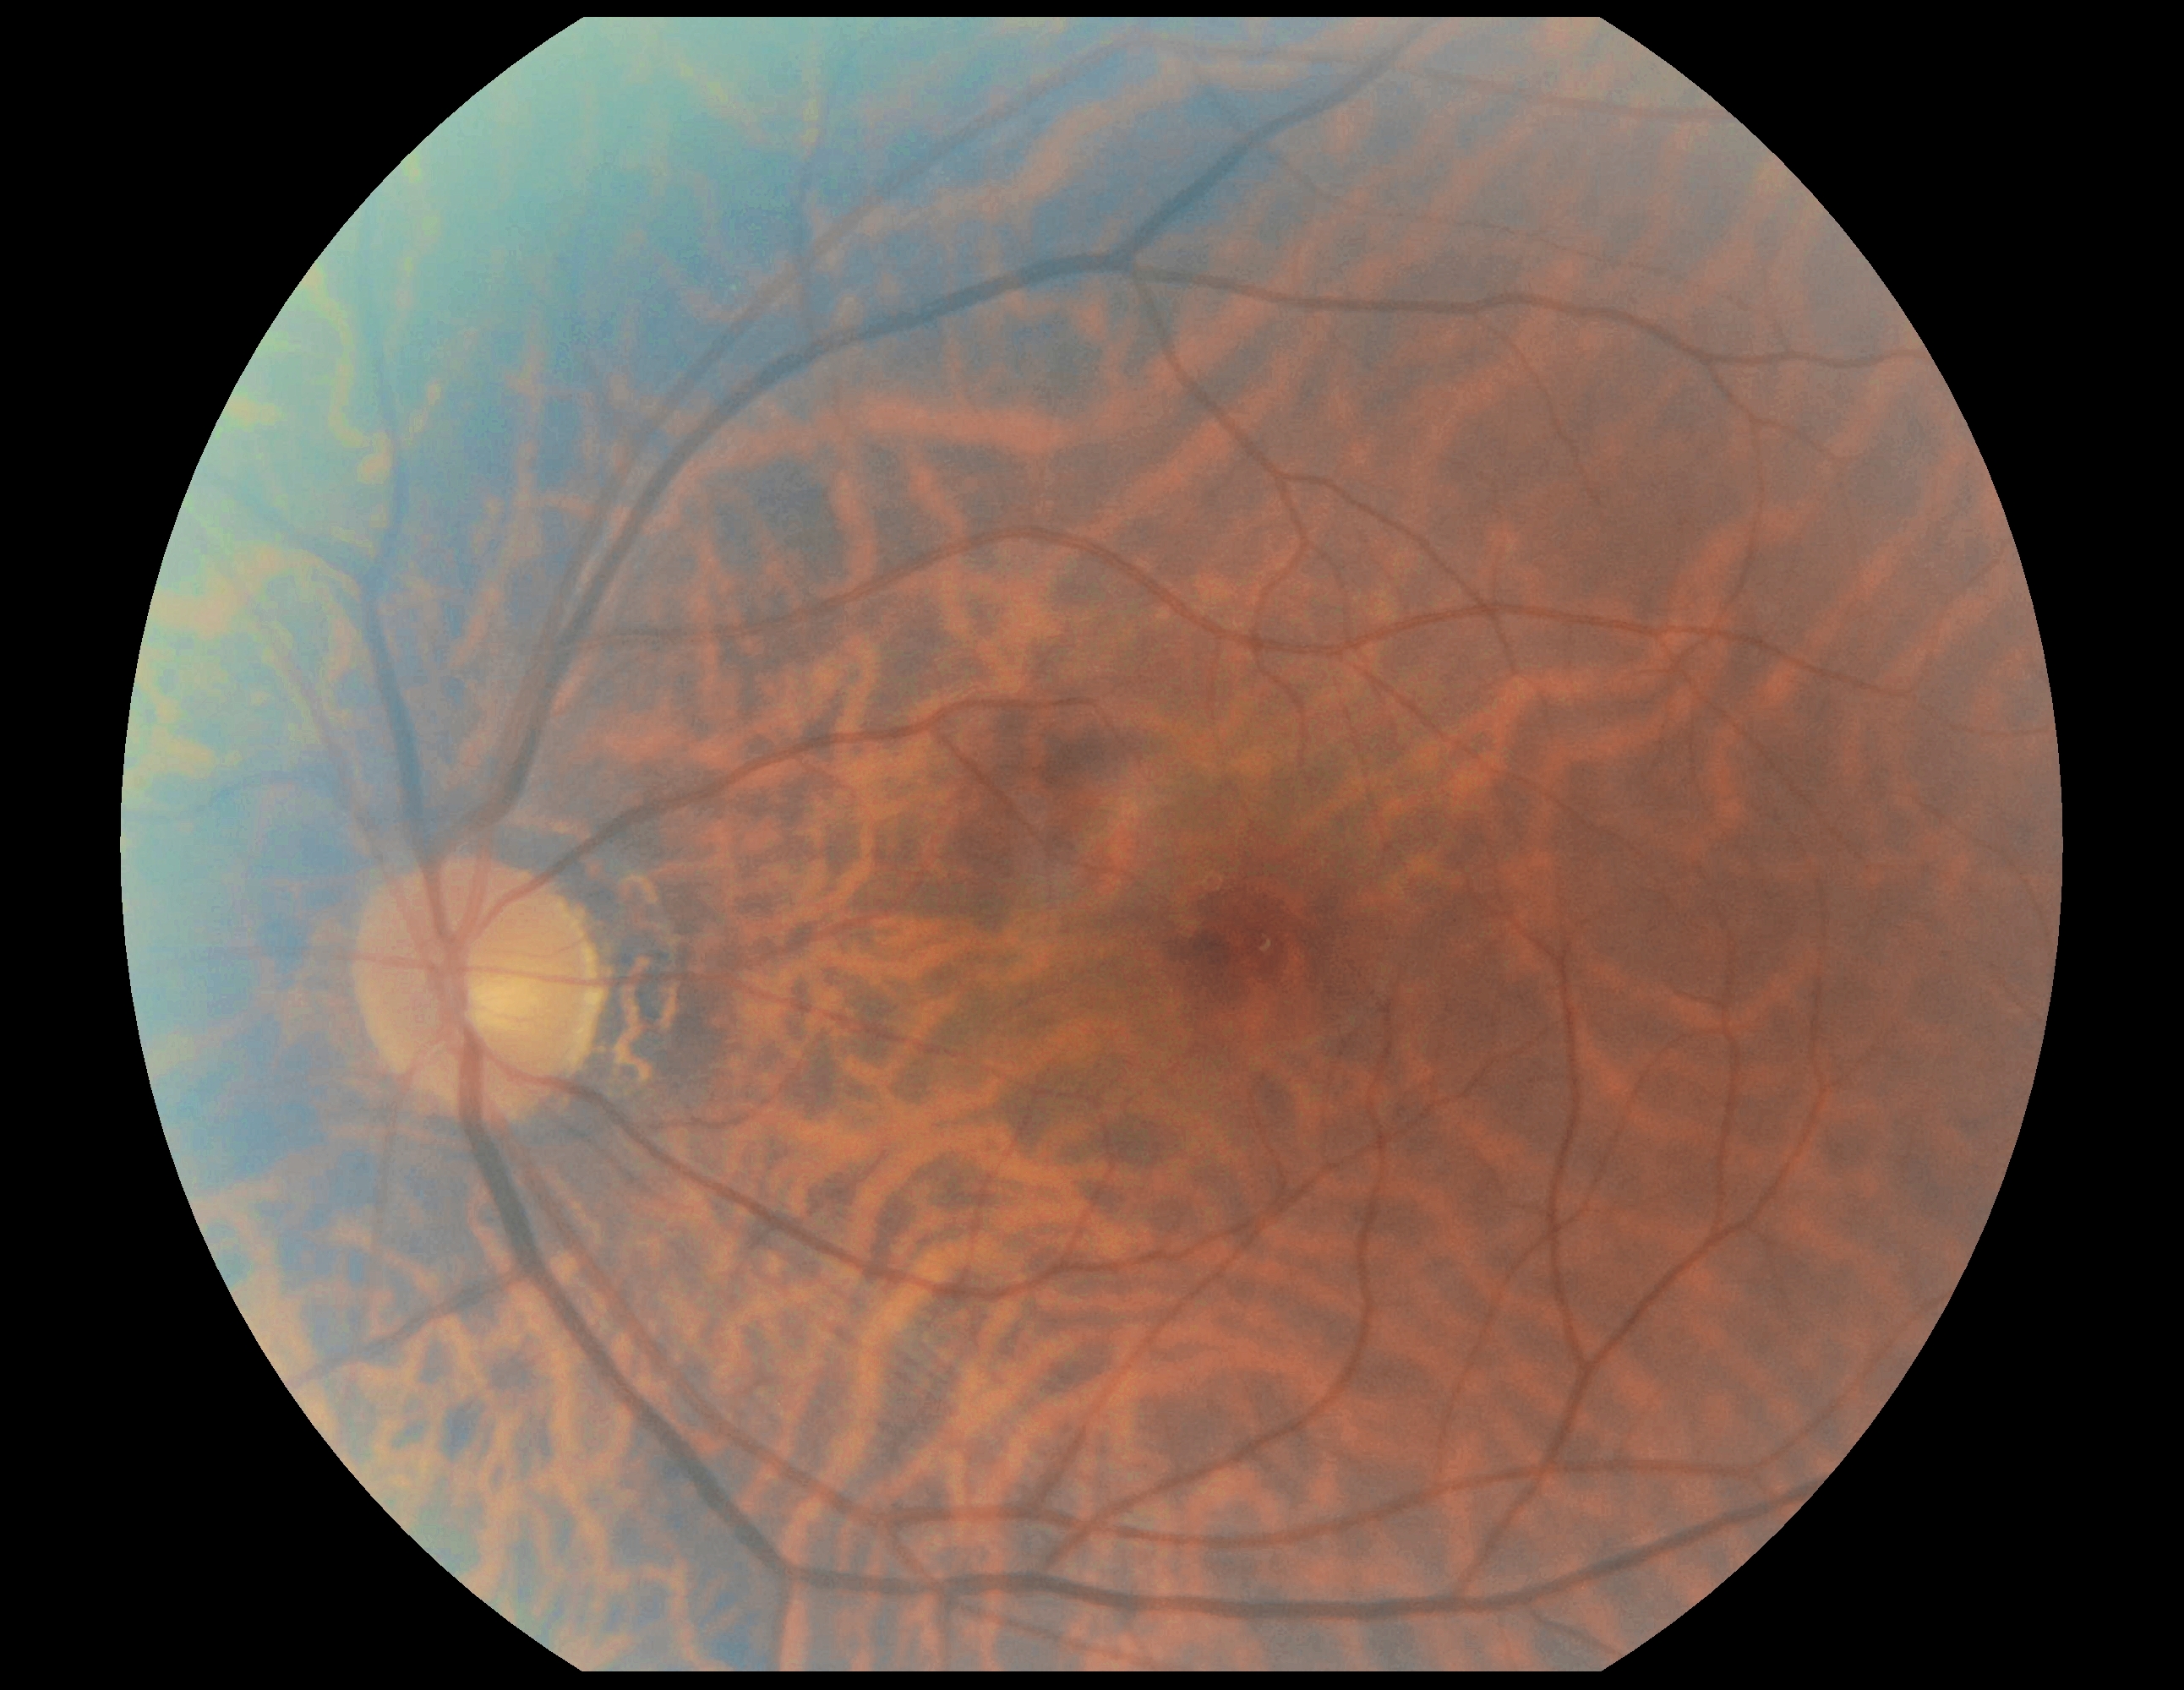 Diabetic retinopathy (DR): 0.